Wide-field fundus photograph of an infant — 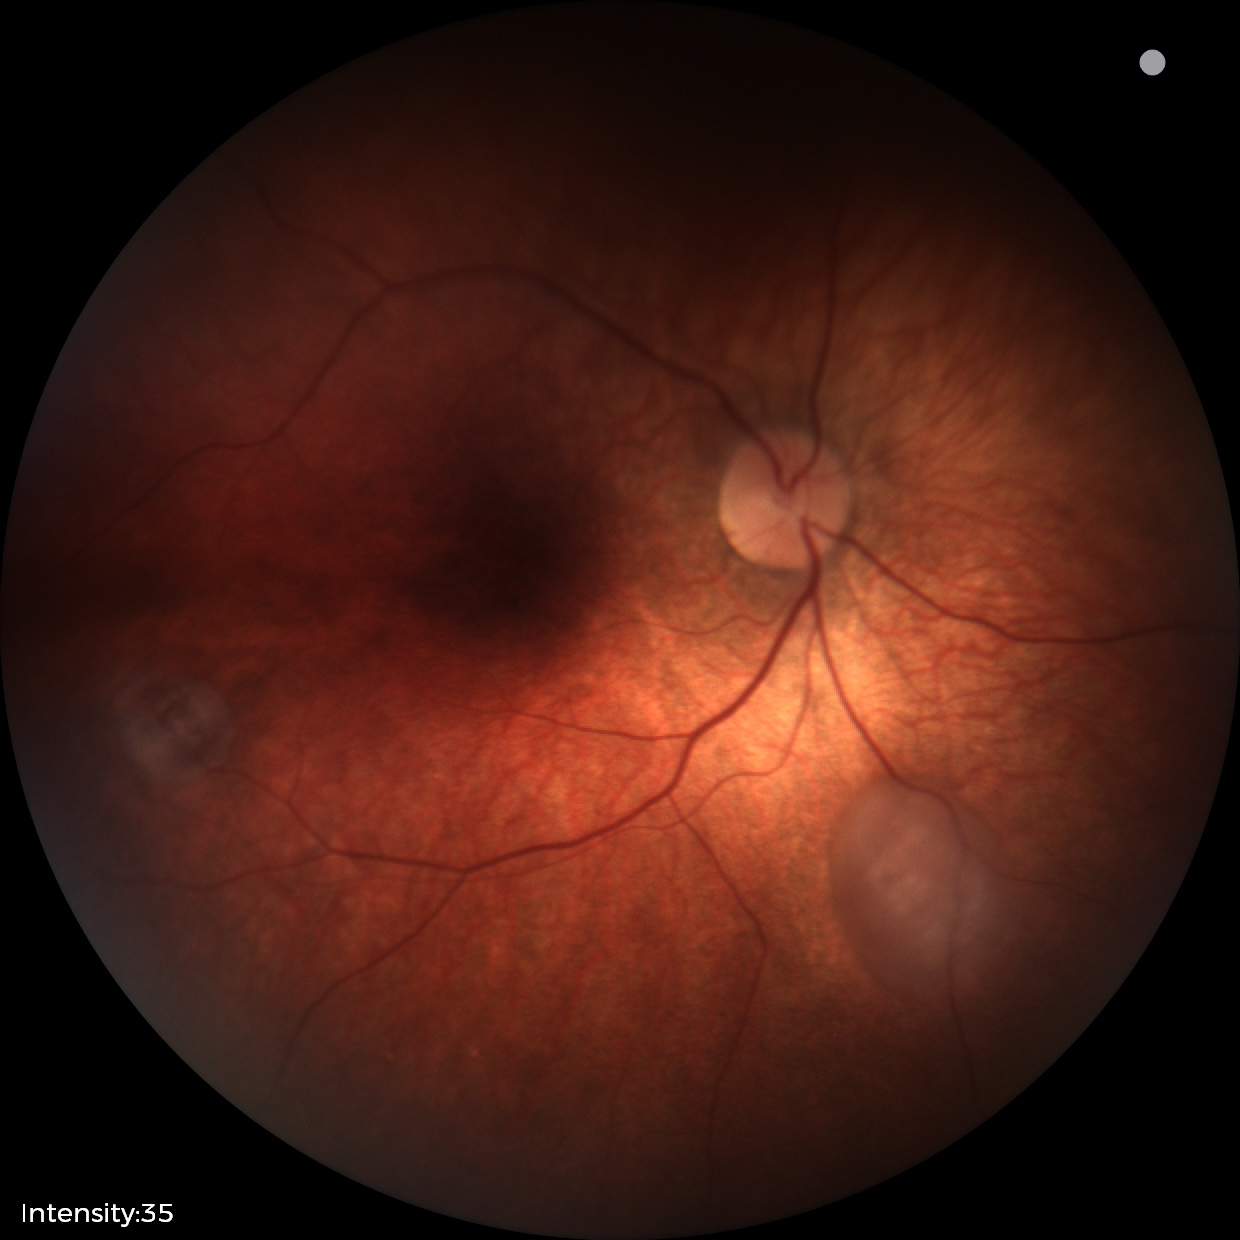 Impression = retinal astrocytic hamartoma.